NIDEK AFC-230 fundus camera. No pharmacologic dilation. Davis DR grading.
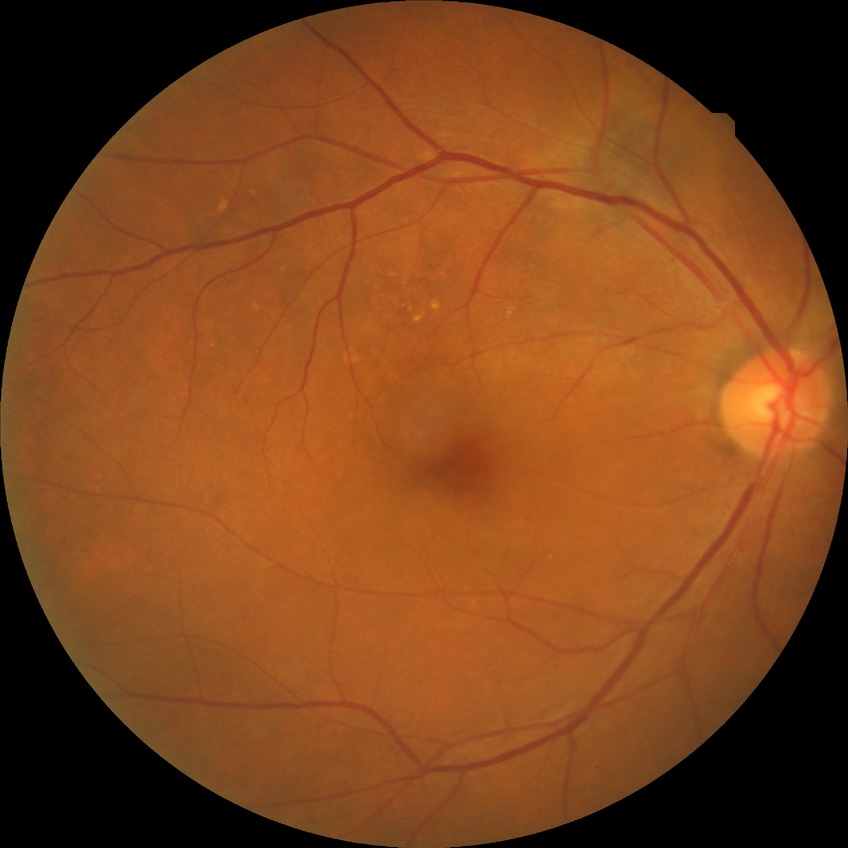 Diabetic retinopathy (DR): no diabetic retinopathy (NDR).